45° field of view: 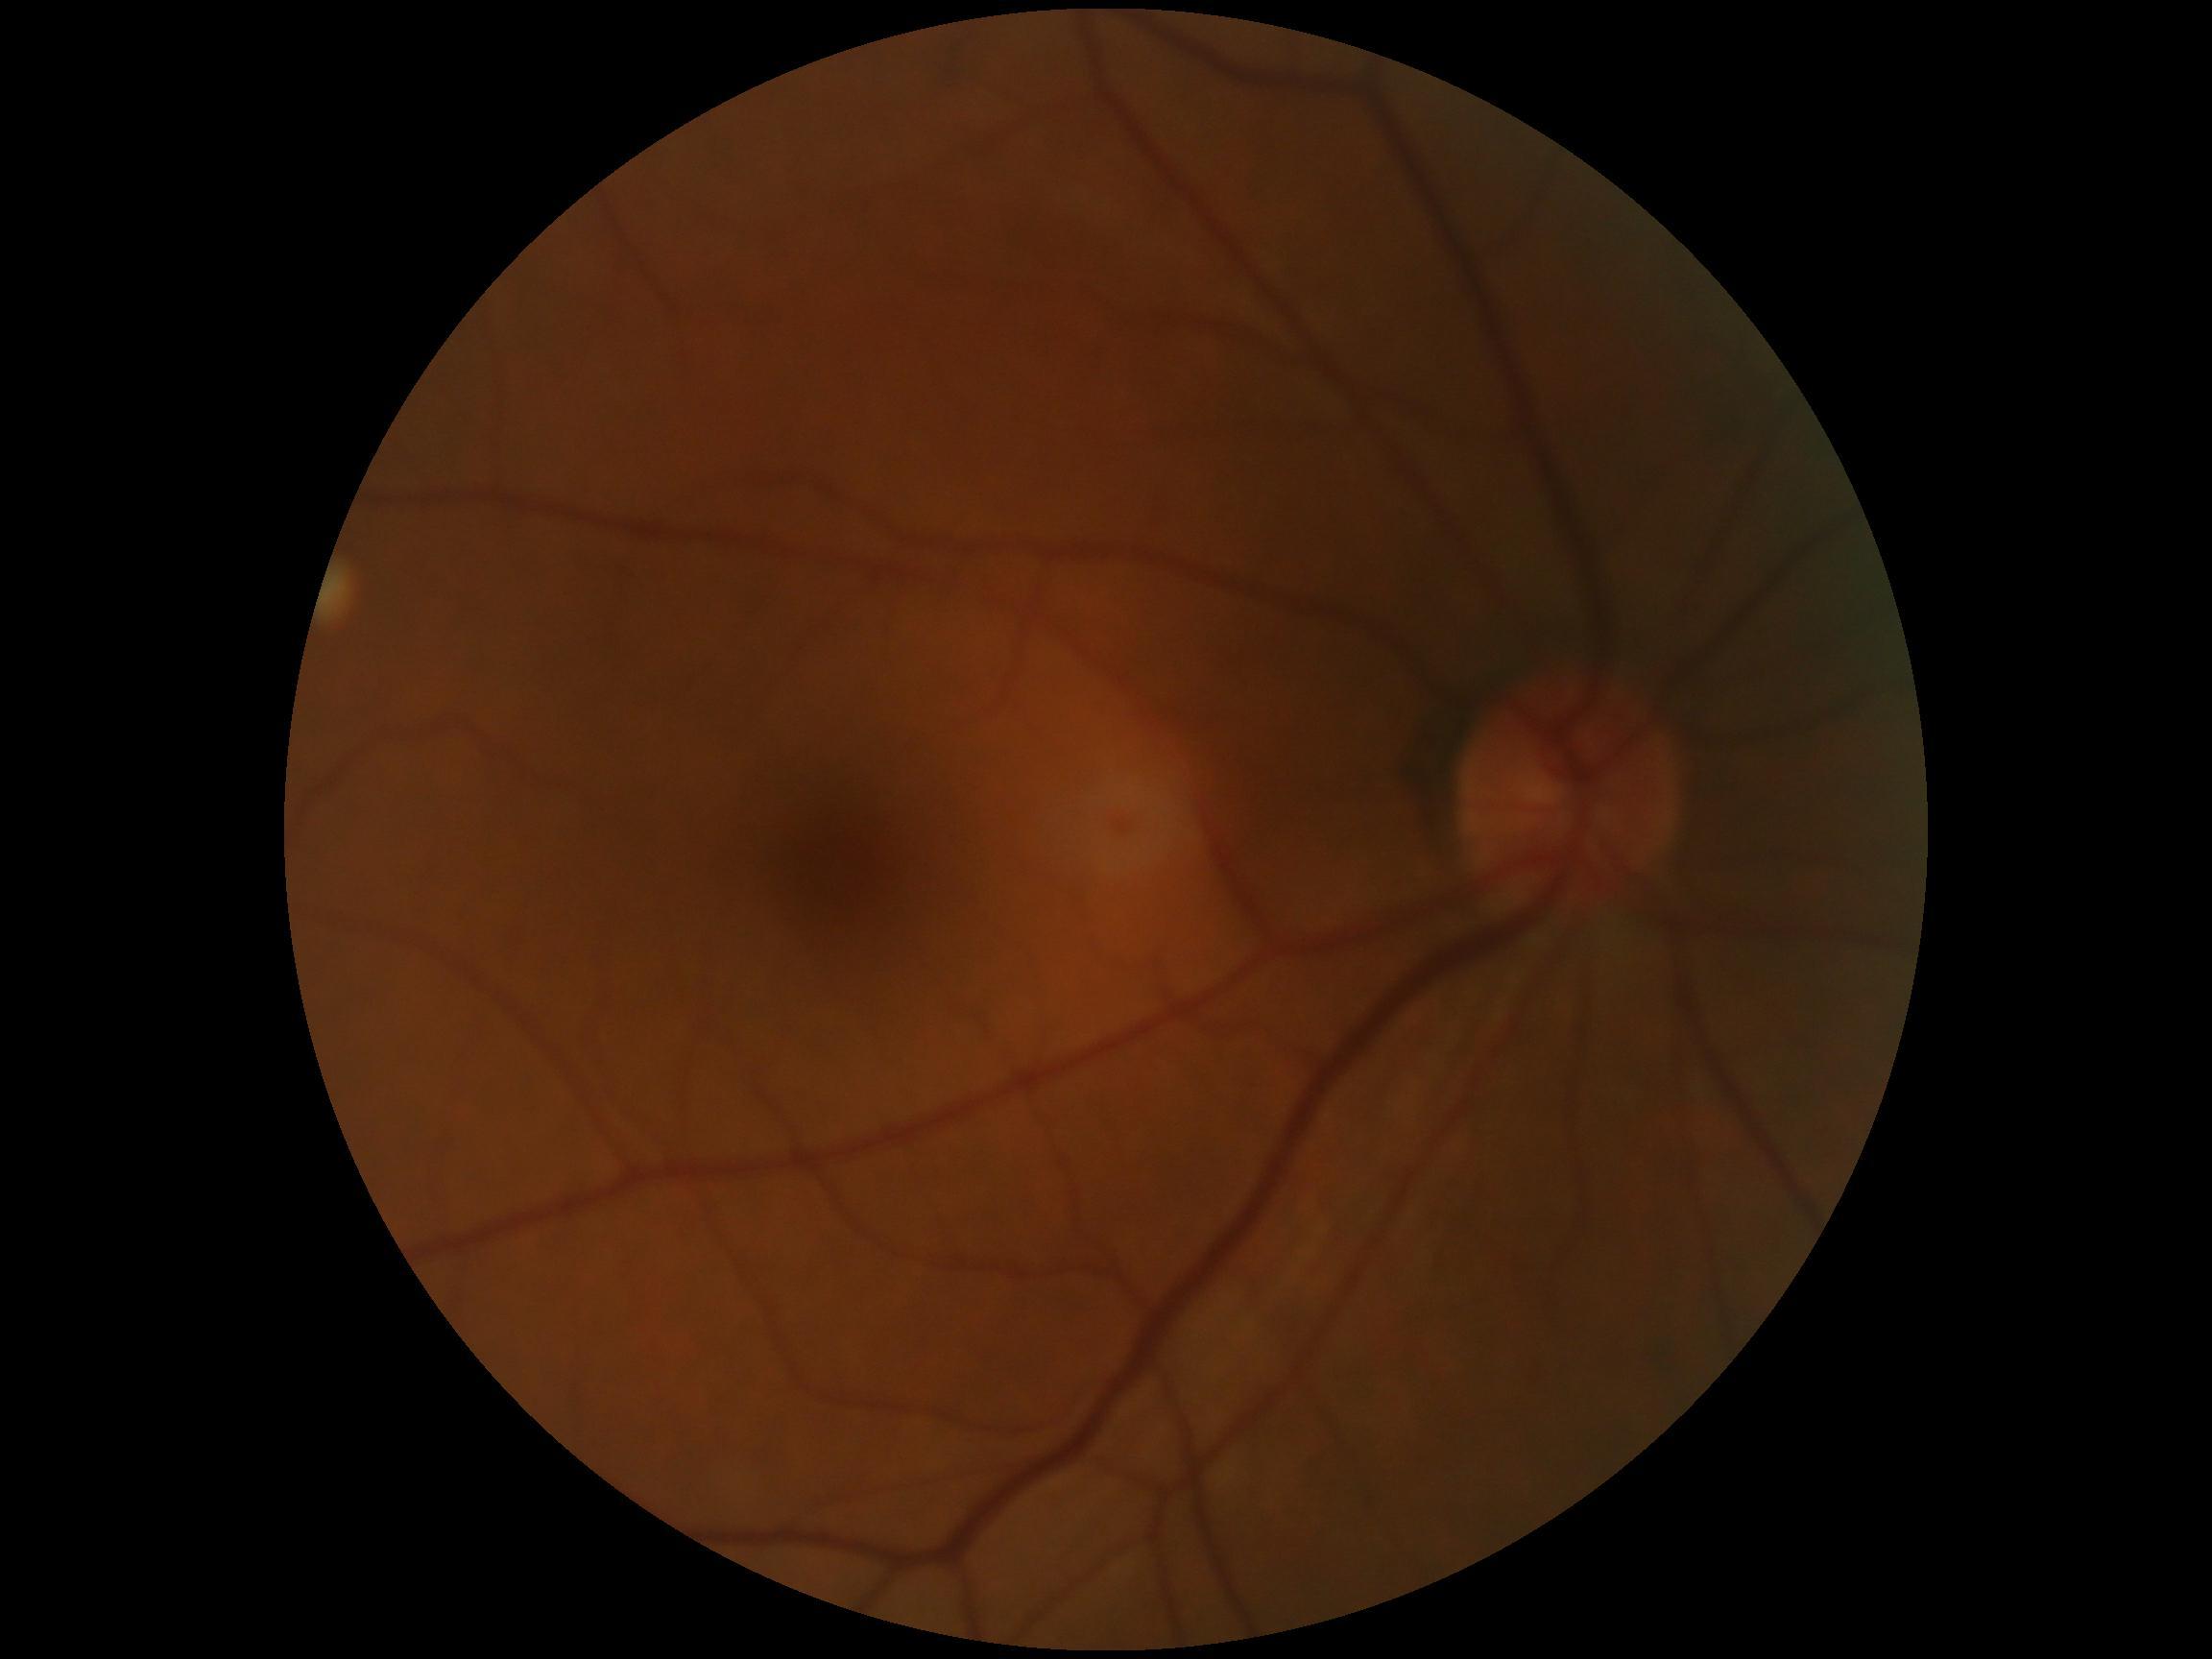
diabetic retinopathy (DR) = grade 0 (no apparent retinopathy).